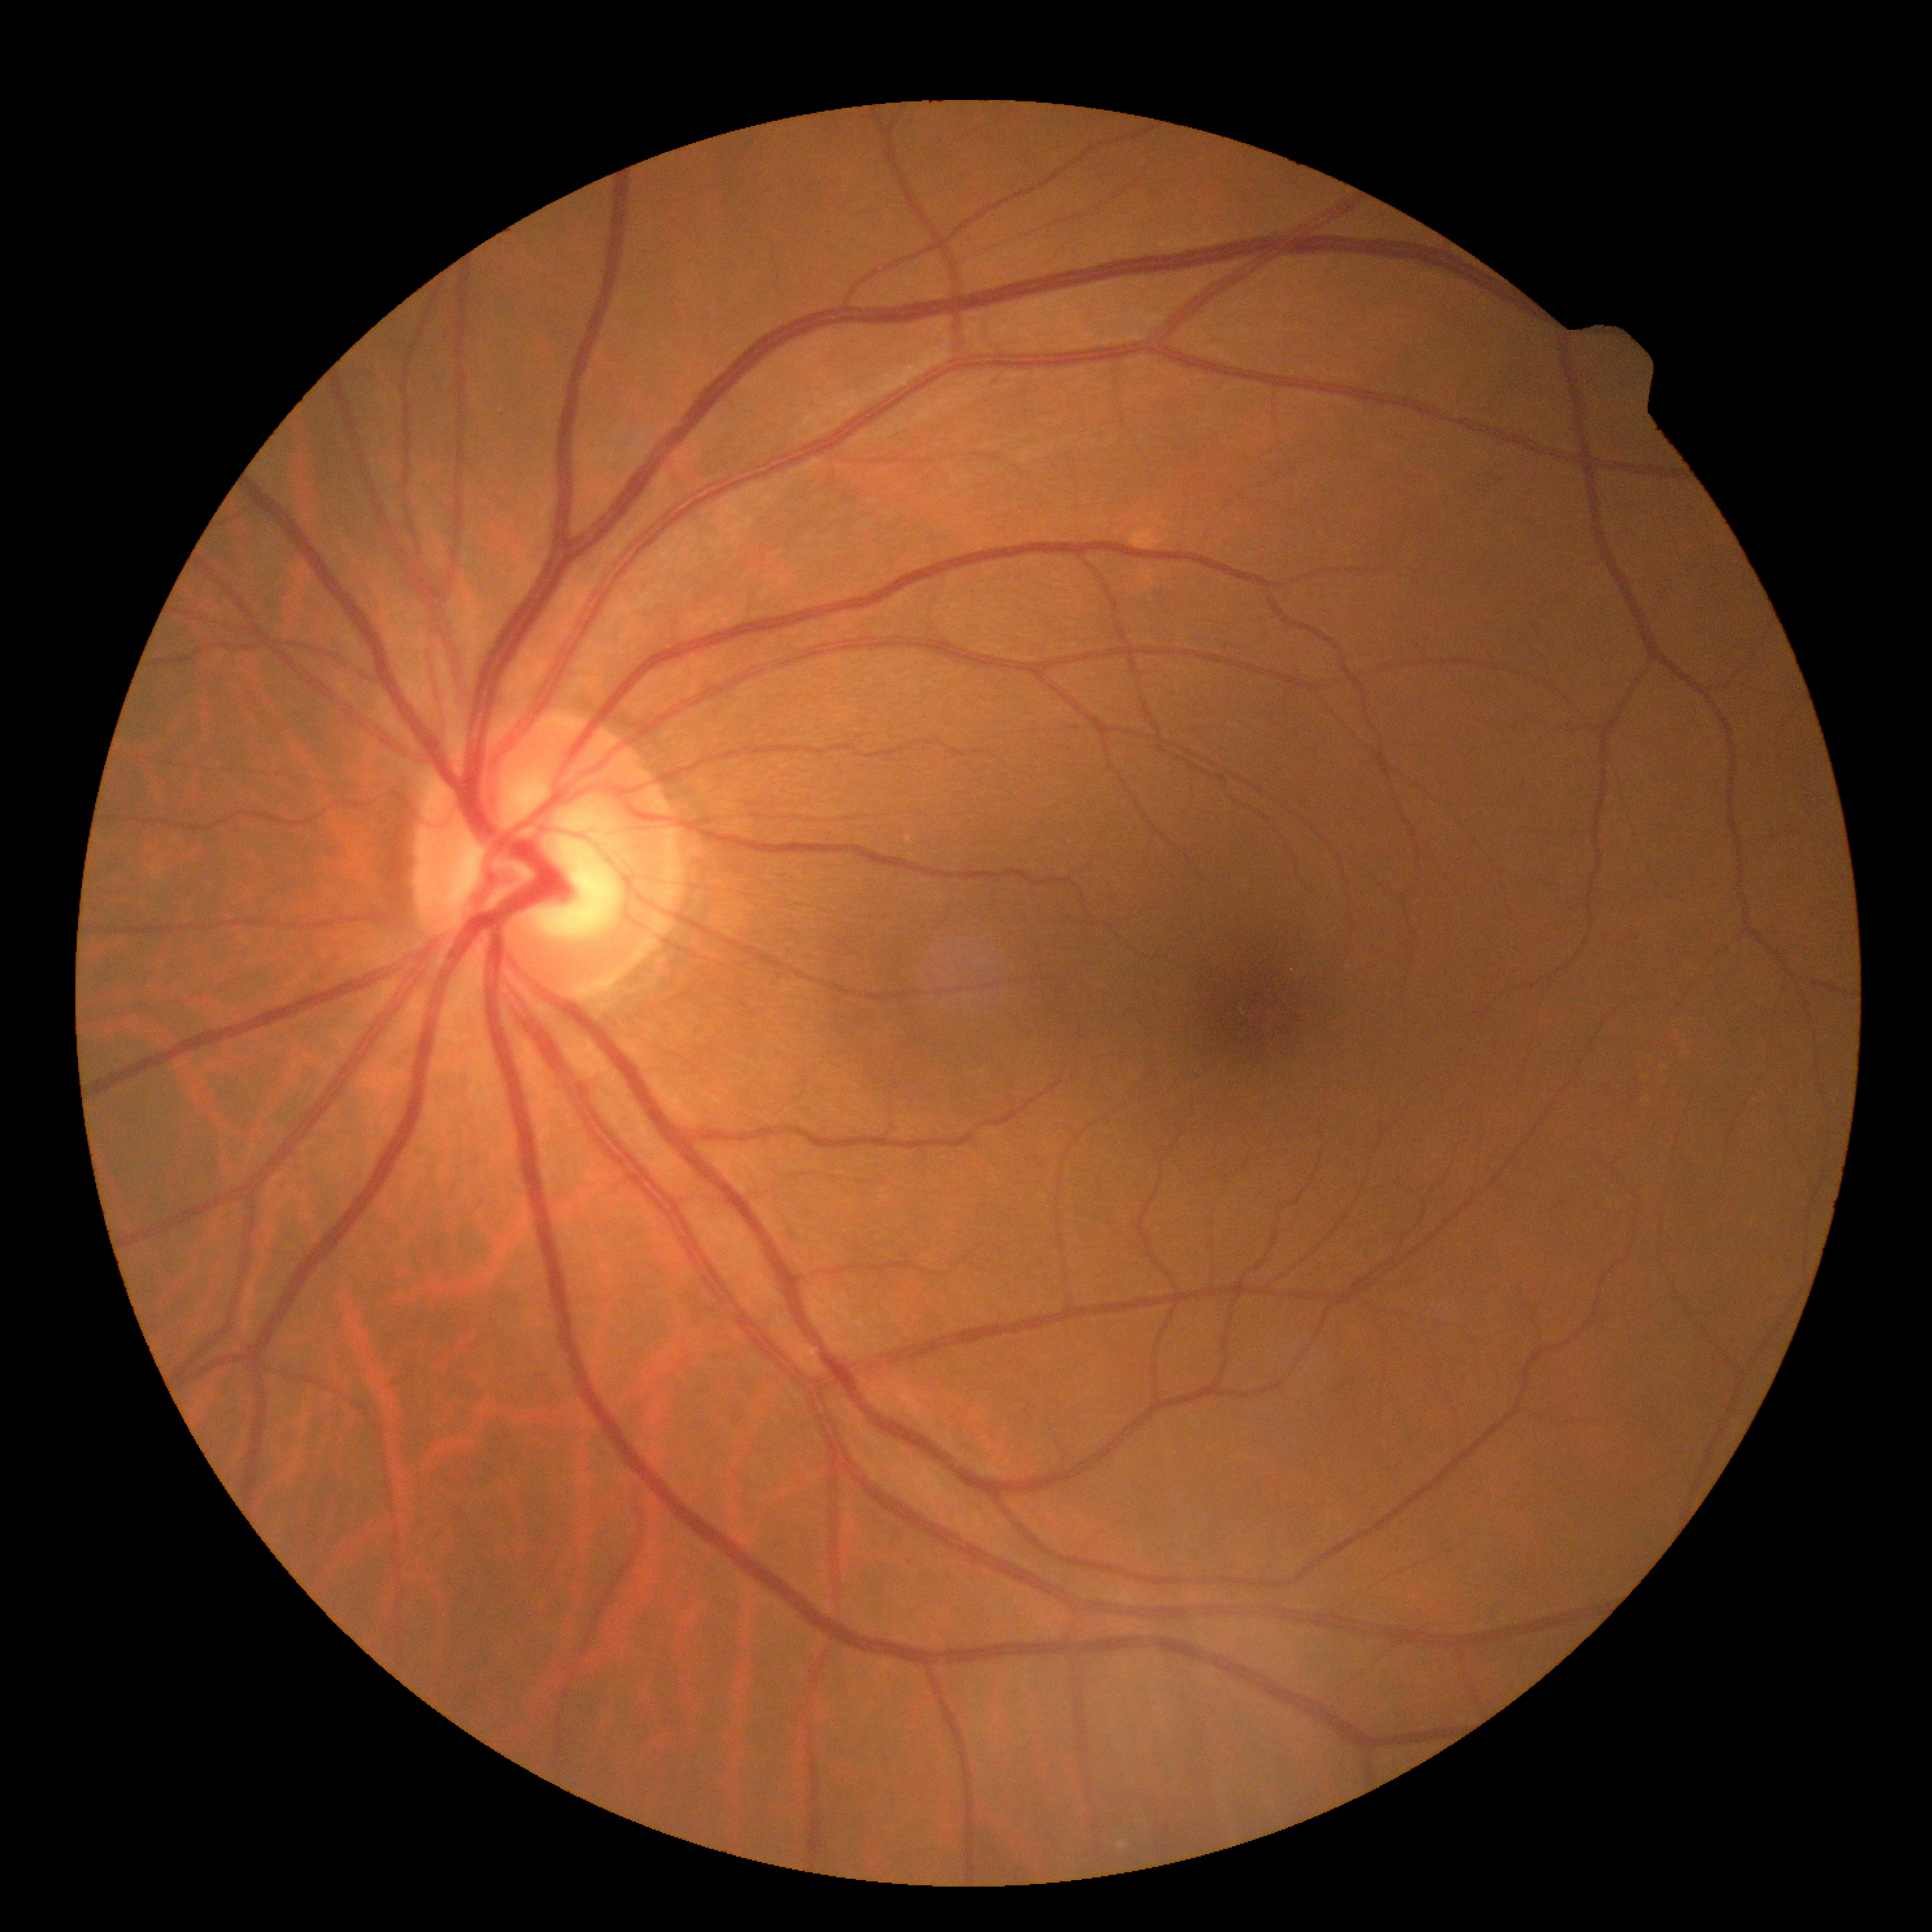

Diabetic retinopathy severity: no apparent diabetic retinopathy (grade 0) — no visible signs of diabetic retinopathy.